45° FOV; CFP:
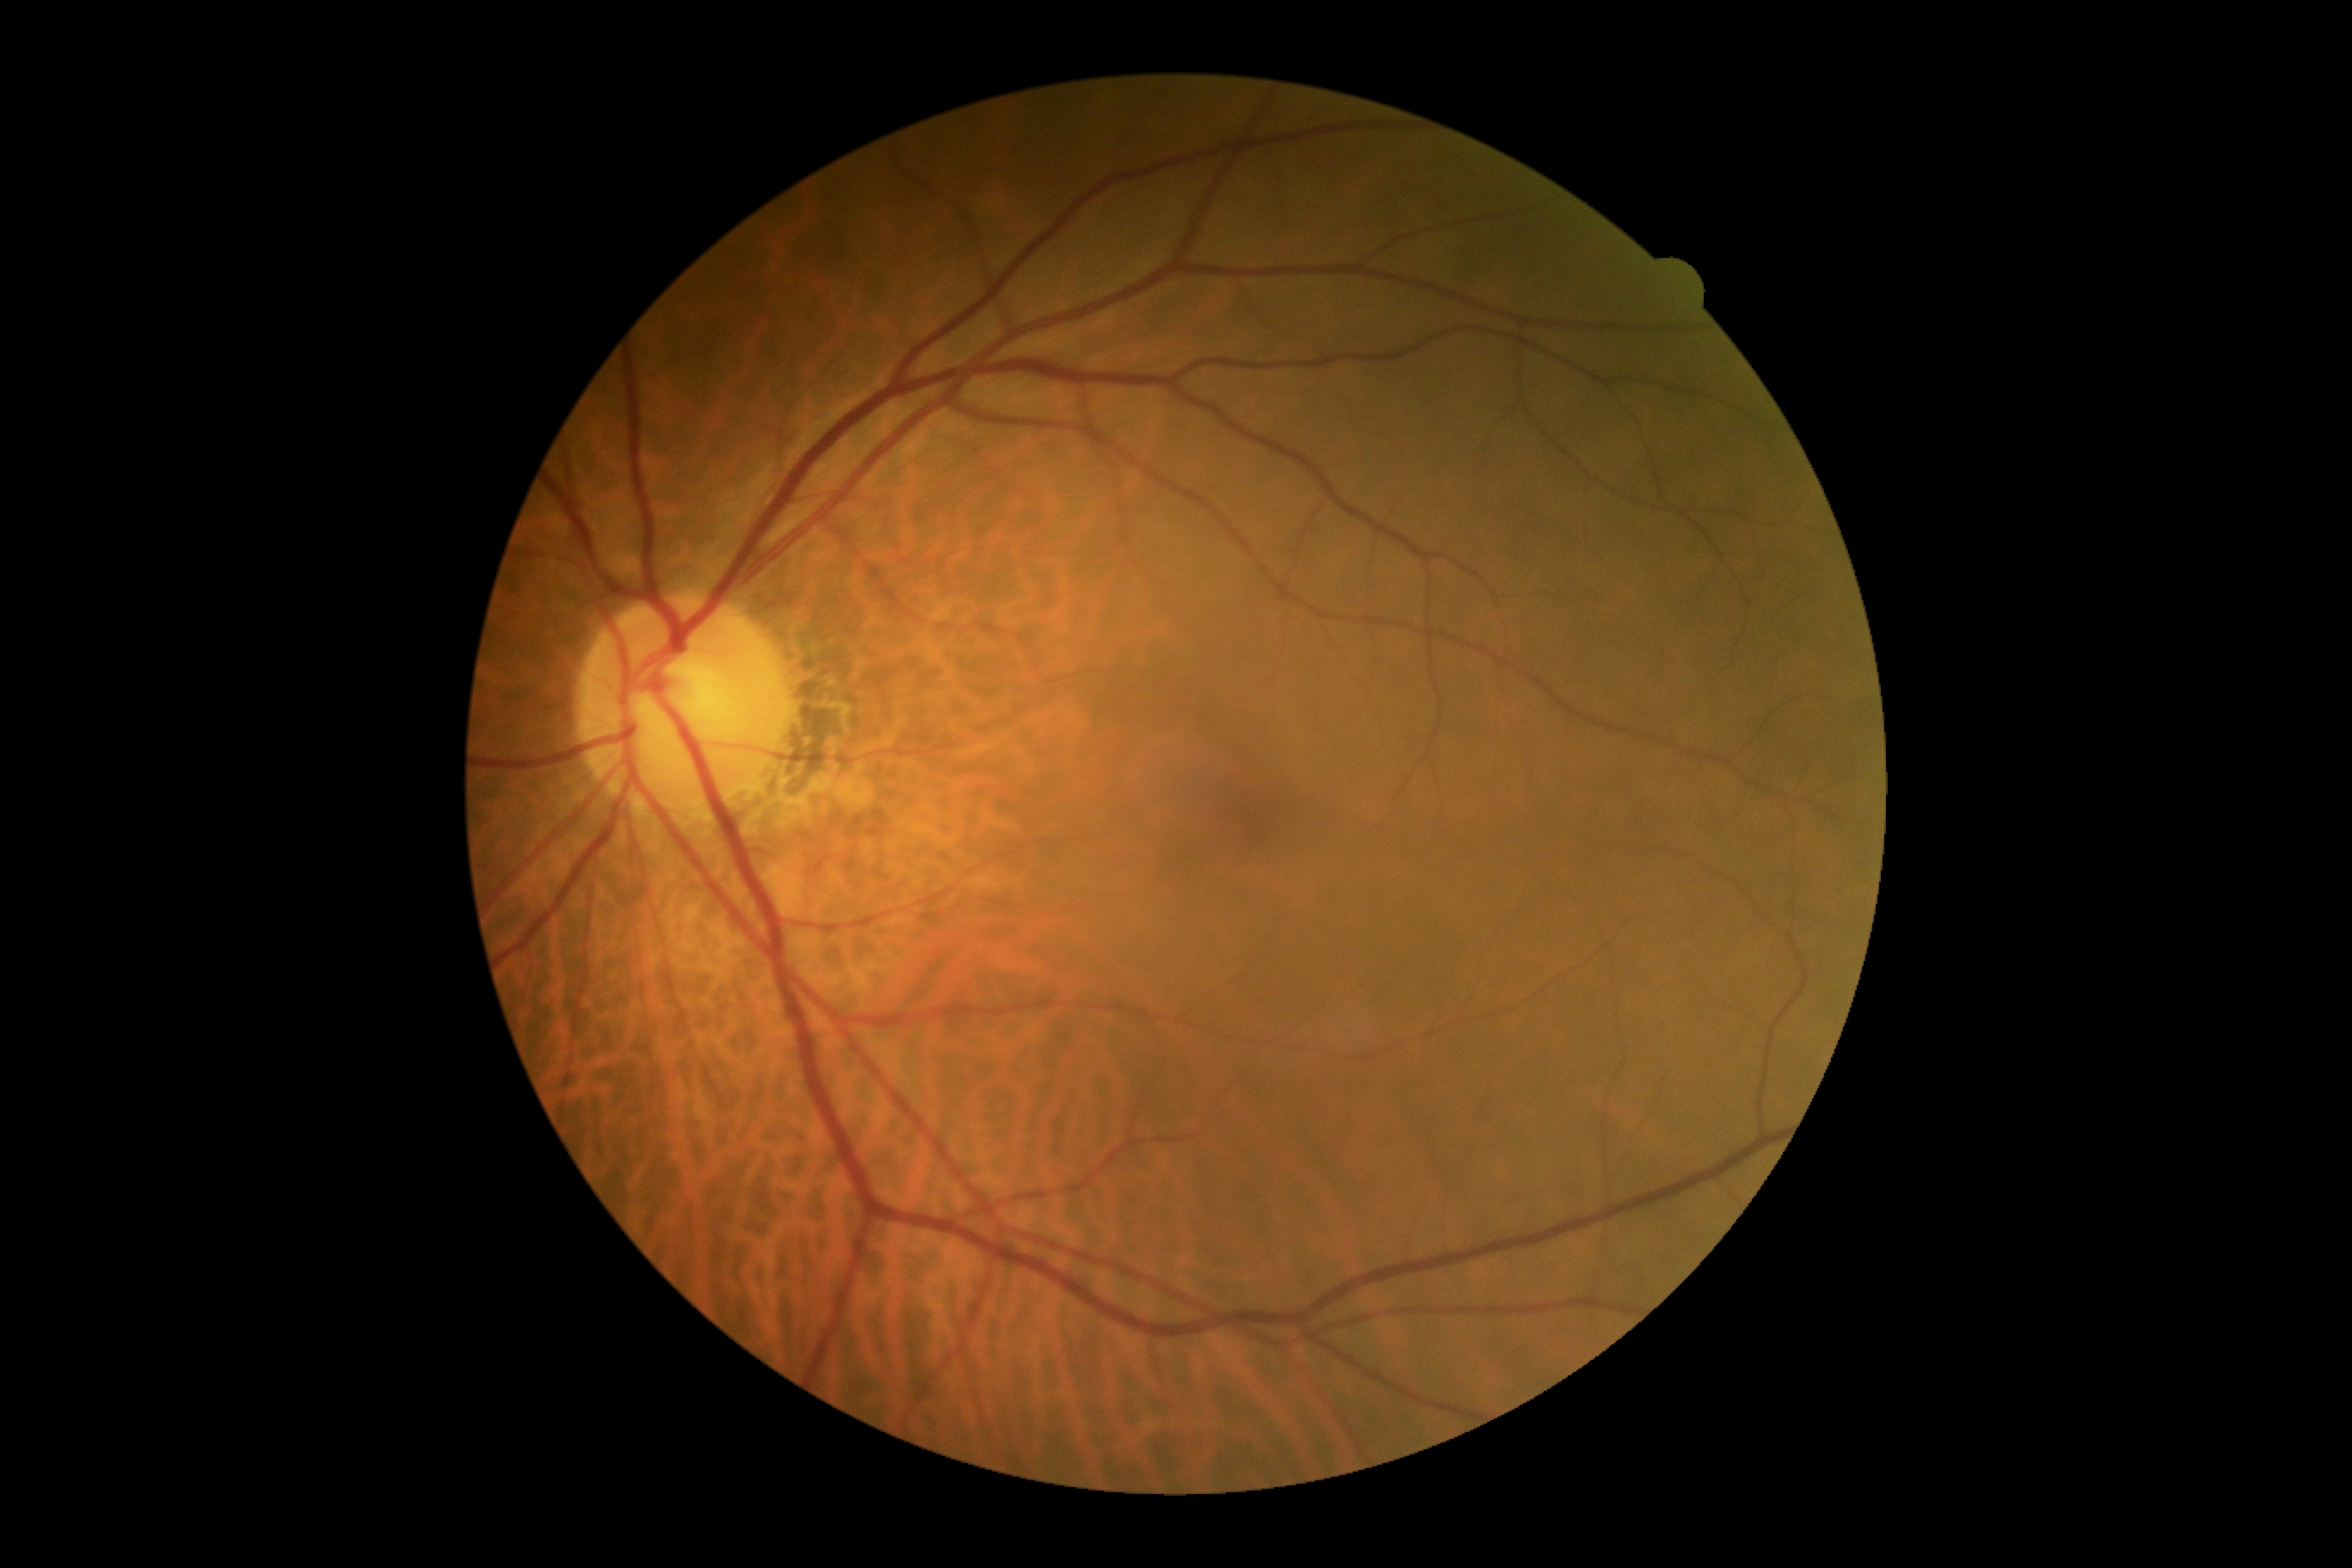 No diabetic retinal disease findings.
Diabetic retinopathy grade: 0 (no apparent retinopathy).